Davis DR grading, NIDEK AFC-230, 45° field of view, fundus photo
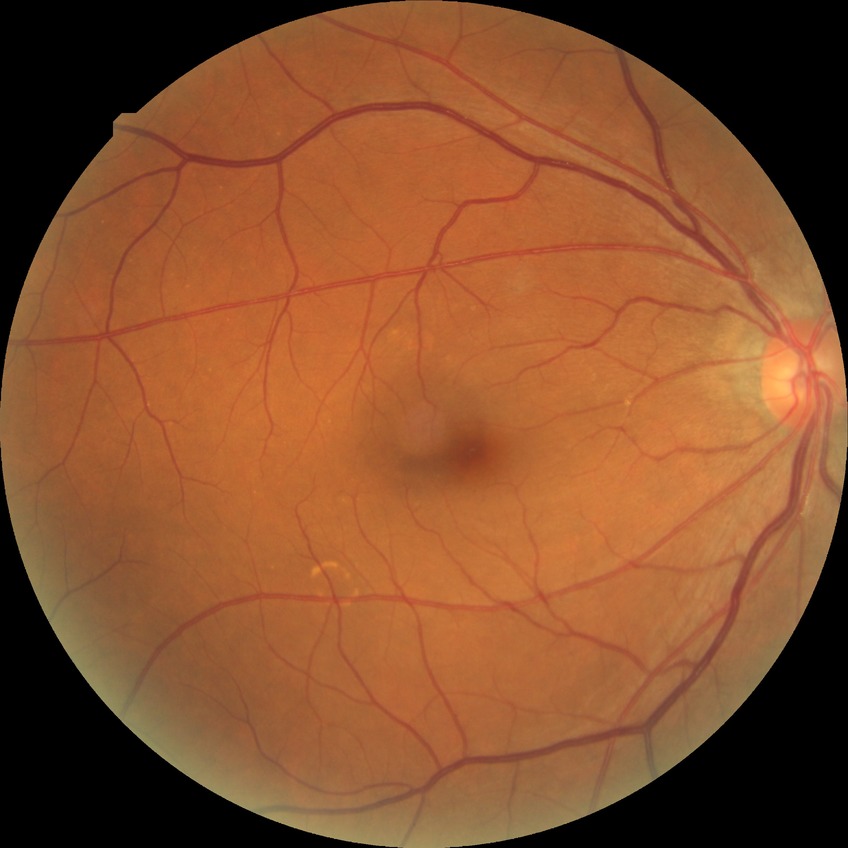 Assessment:
– diabetic retinopathy (DR) — NDR (no diabetic retinopathy)